45° FOV, posterior pole photograph, 848 x 848 pixels
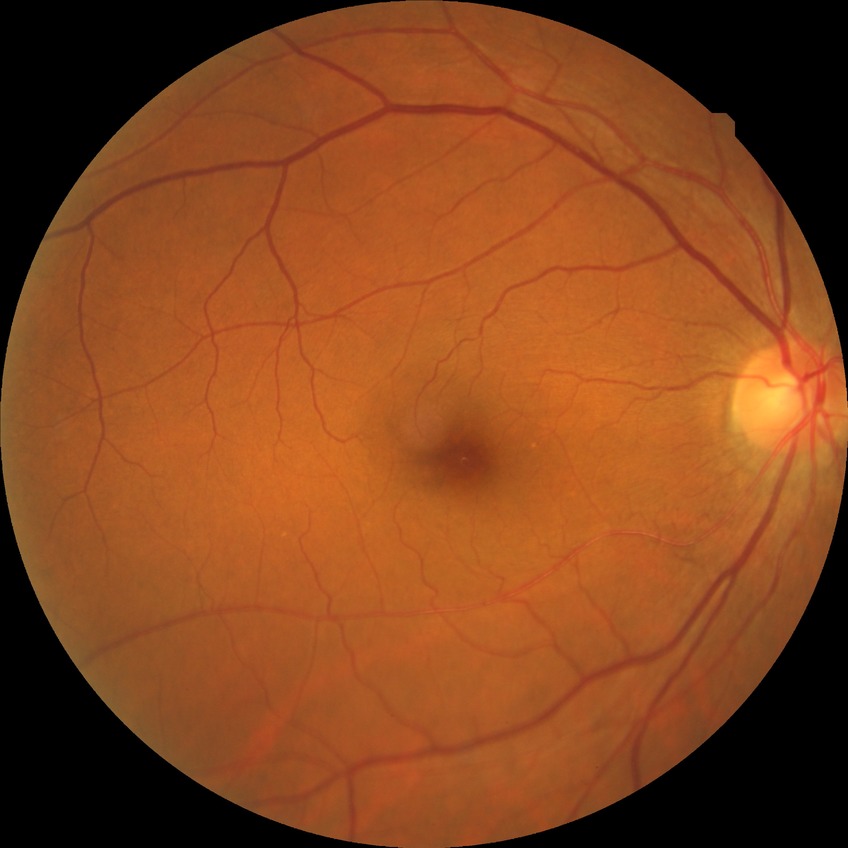

Diabetic retinopathy (DR): NDR (no diabetic retinopathy).